Infant wide-field fundus photograph: 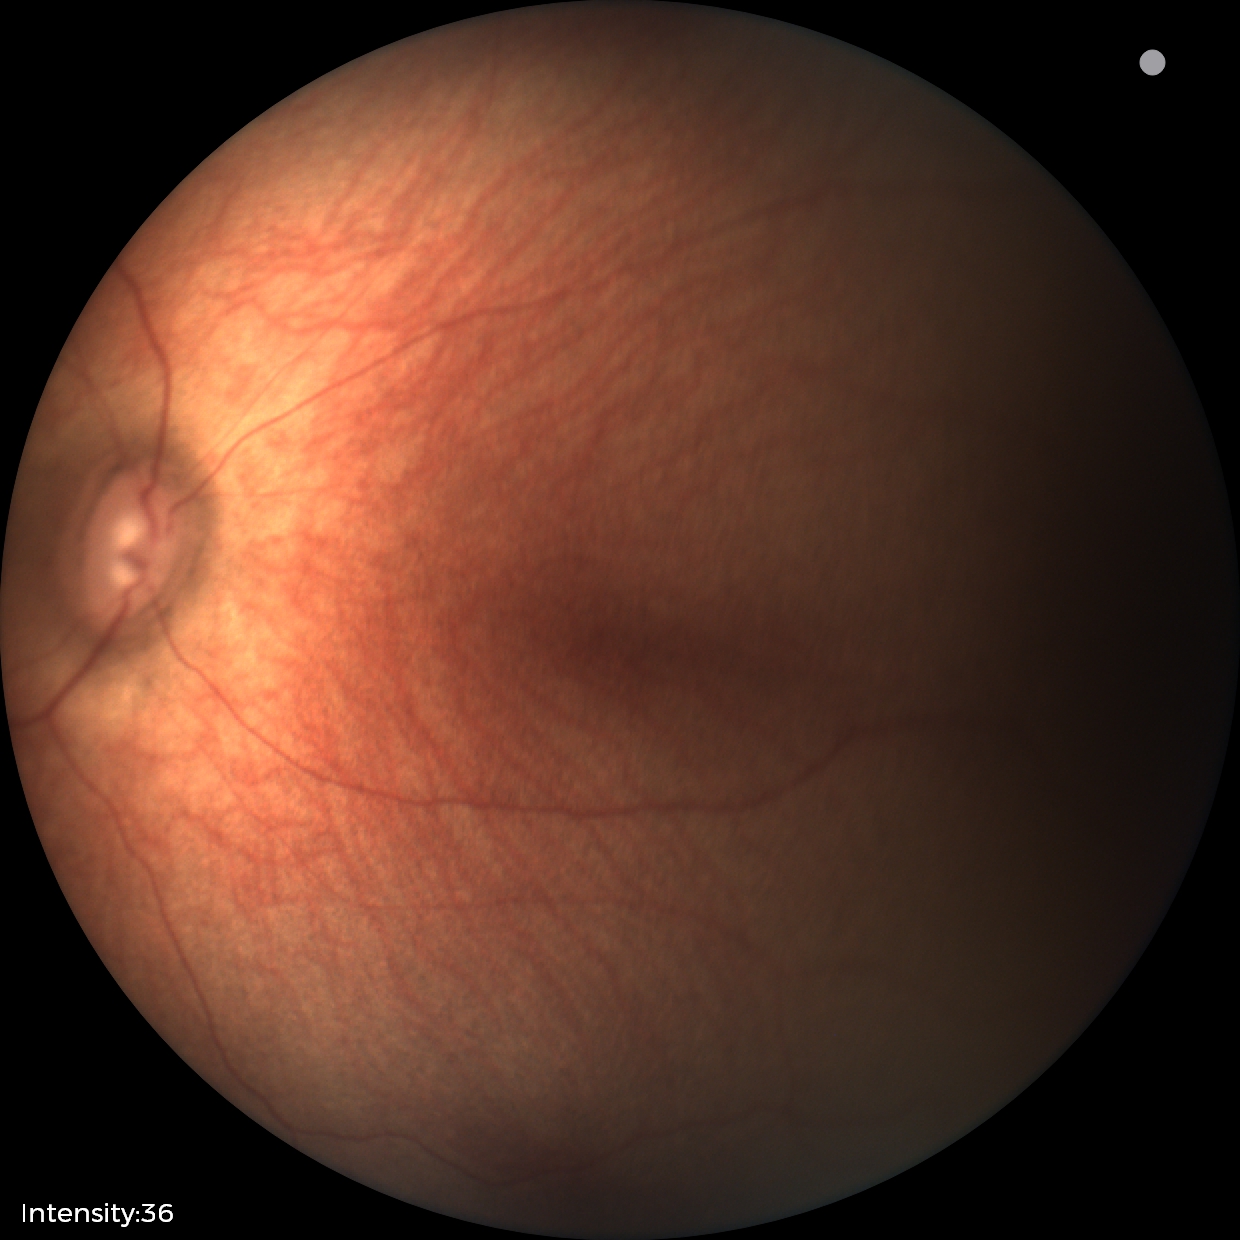

Q: What is the diagnosis from this examination?
A: physiological finding